Color fundus image. FOV: 45 degrees
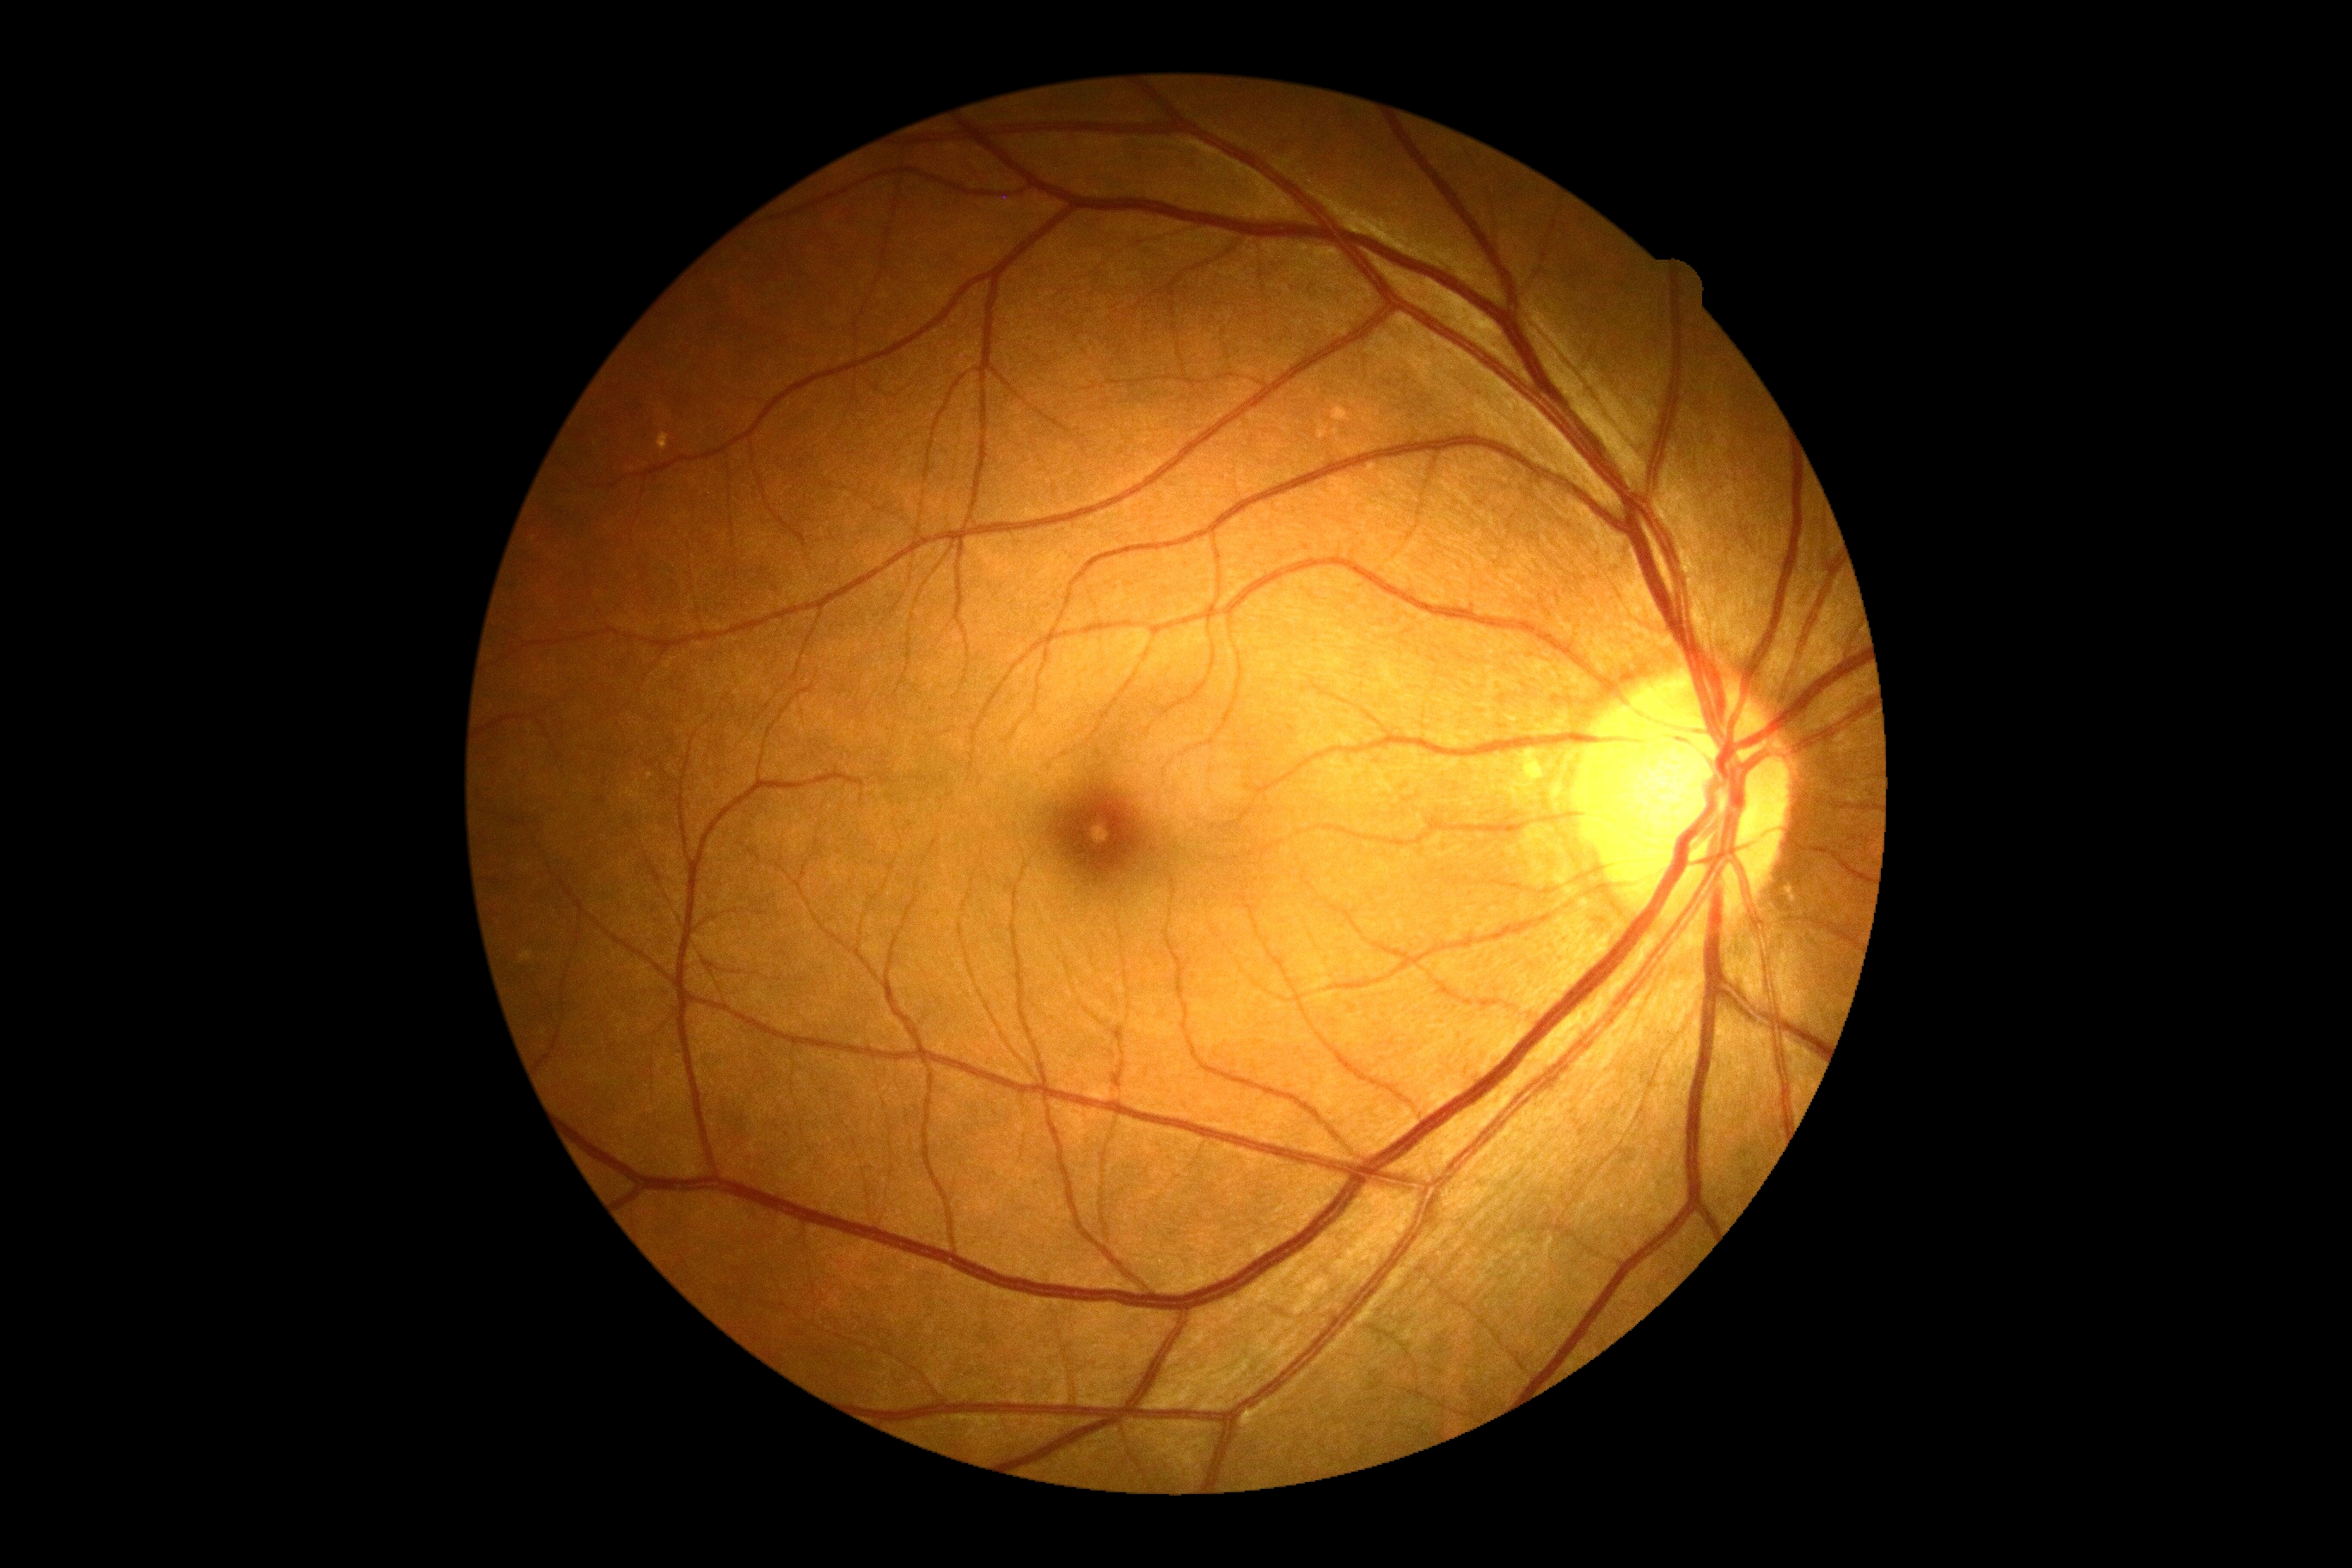

DR: grade 0.